Infant wide-field retinal image
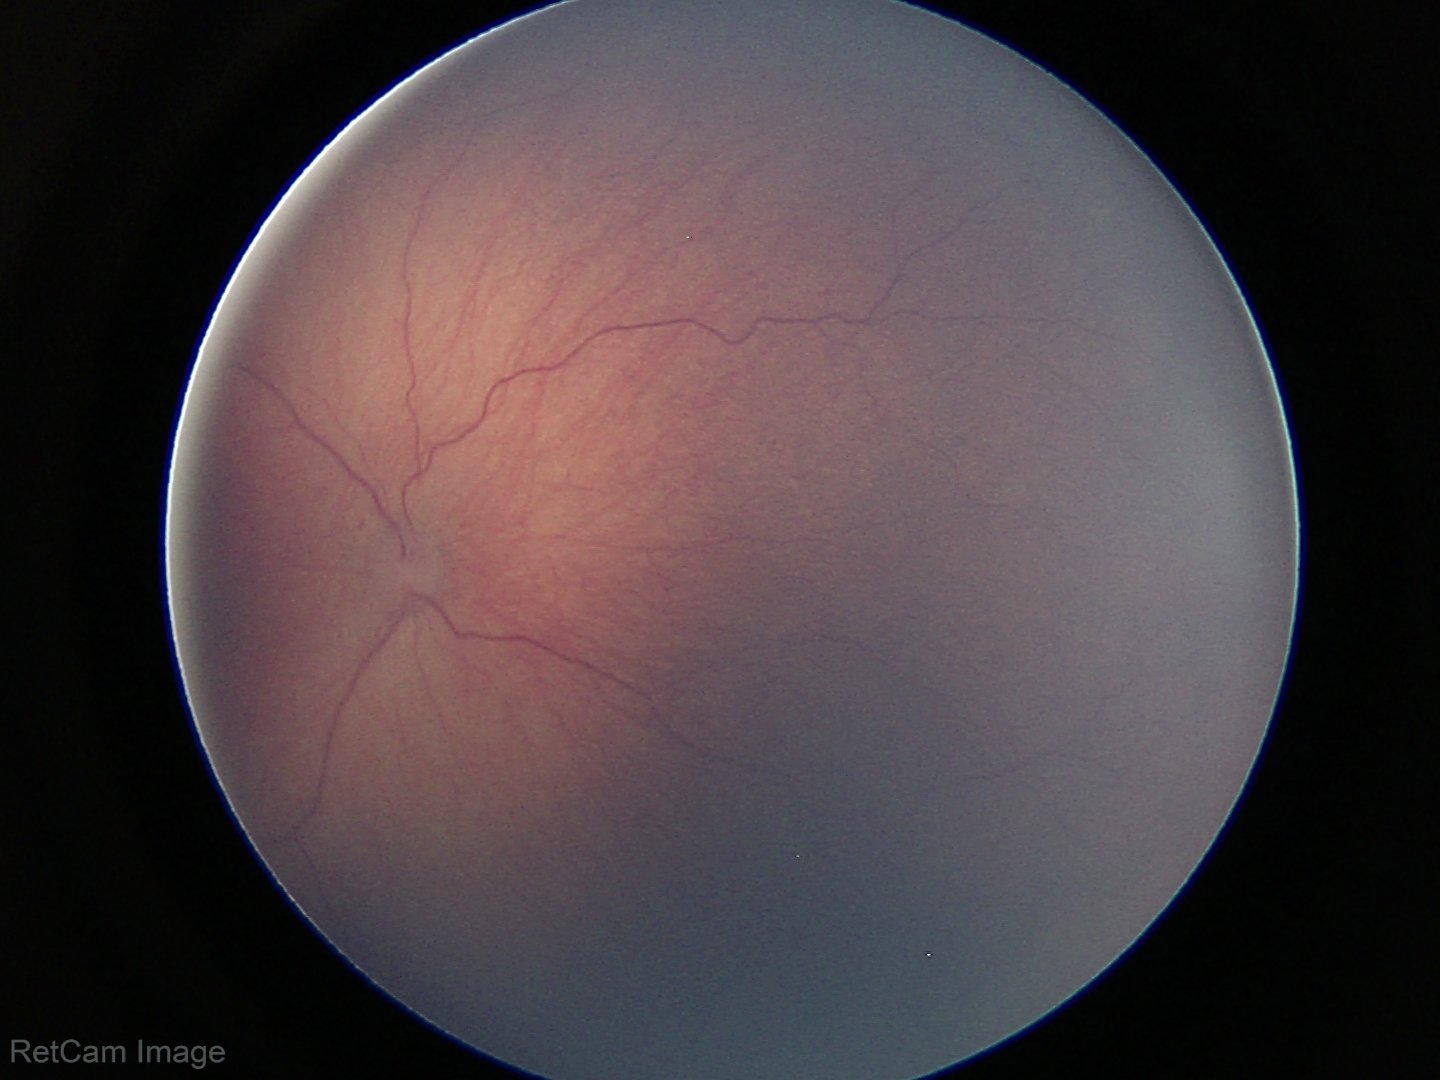

Assessment: retinopathy of prematurity stage 1, plus form: absent.